Camera: NIDEK AFC-230; 45 degree fundus photograph: 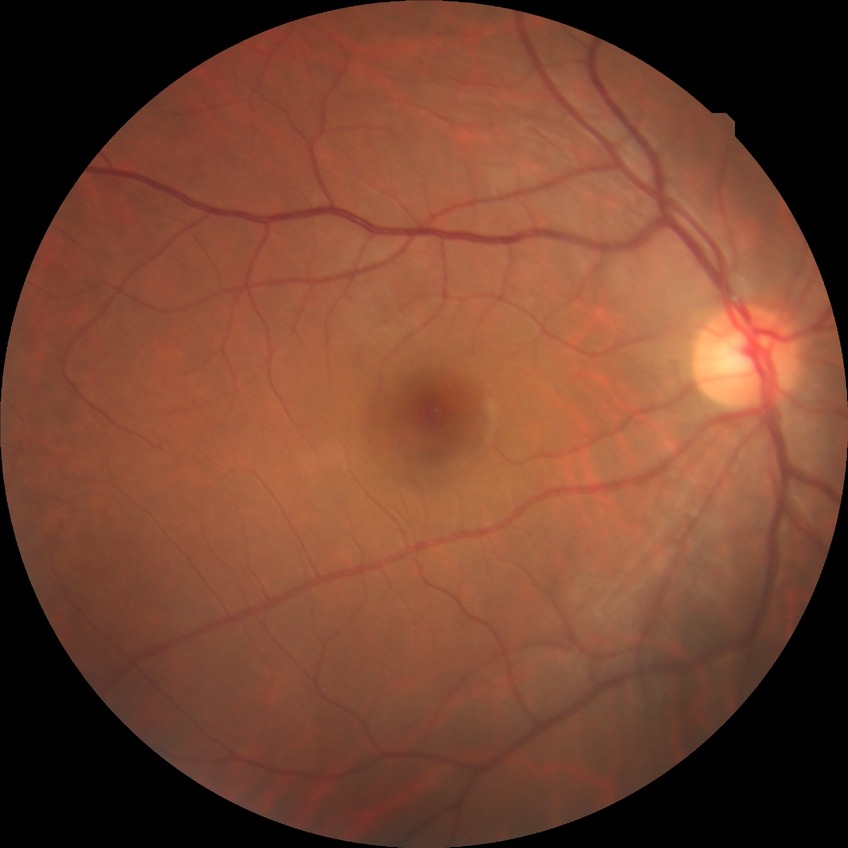

Diabetic retinopathy (DR) is no diabetic retinopathy (NDR).